Fundus photo, camera: NIDEK AFC-230, 848x848, without pupil dilation.
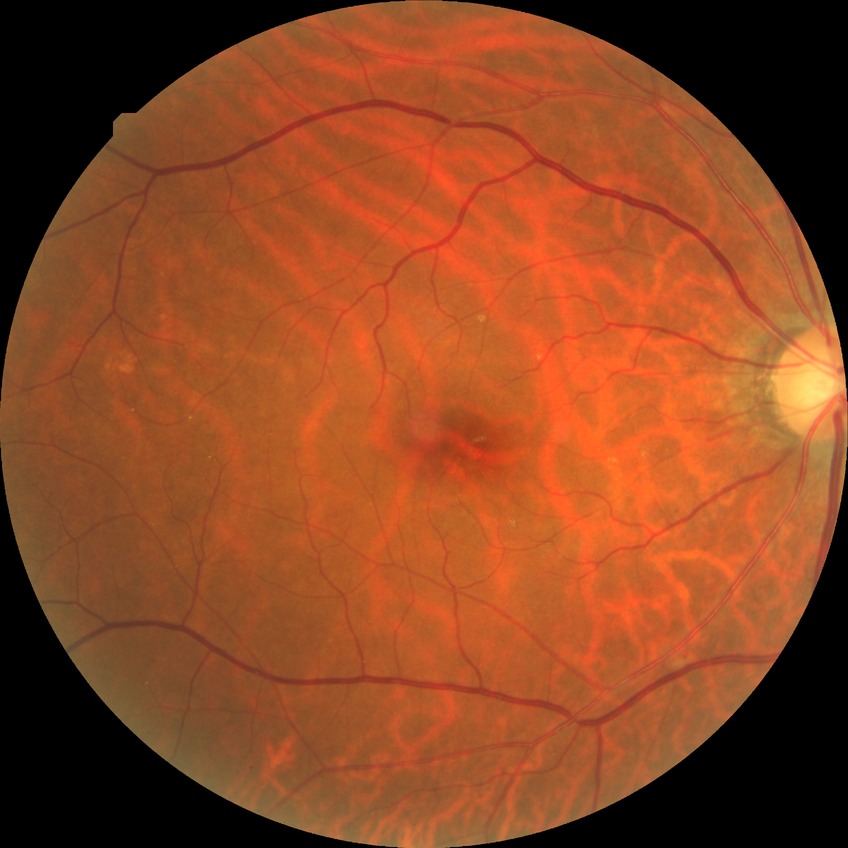

Retinopathy stage is simple diabetic retinopathy.